45° FOV; nonmydriatic: 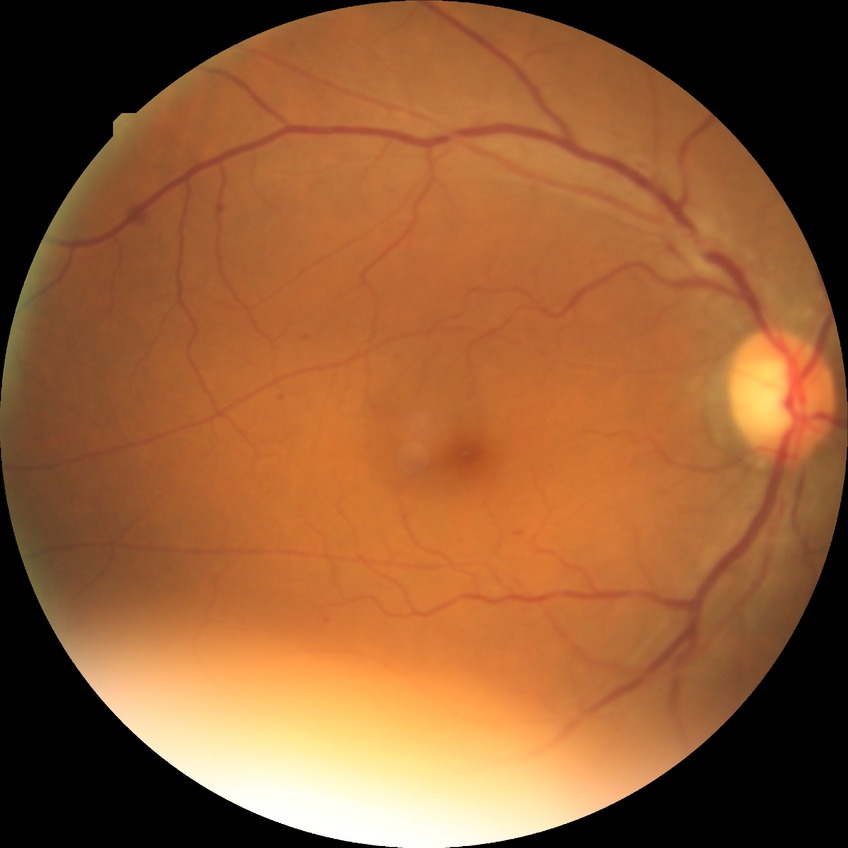
Disease class: non-proliferative diabetic retinopathy. Diabetic retinopathy (DR): SDR (simple diabetic retinopathy).